Wide-field retinal mosaic image.
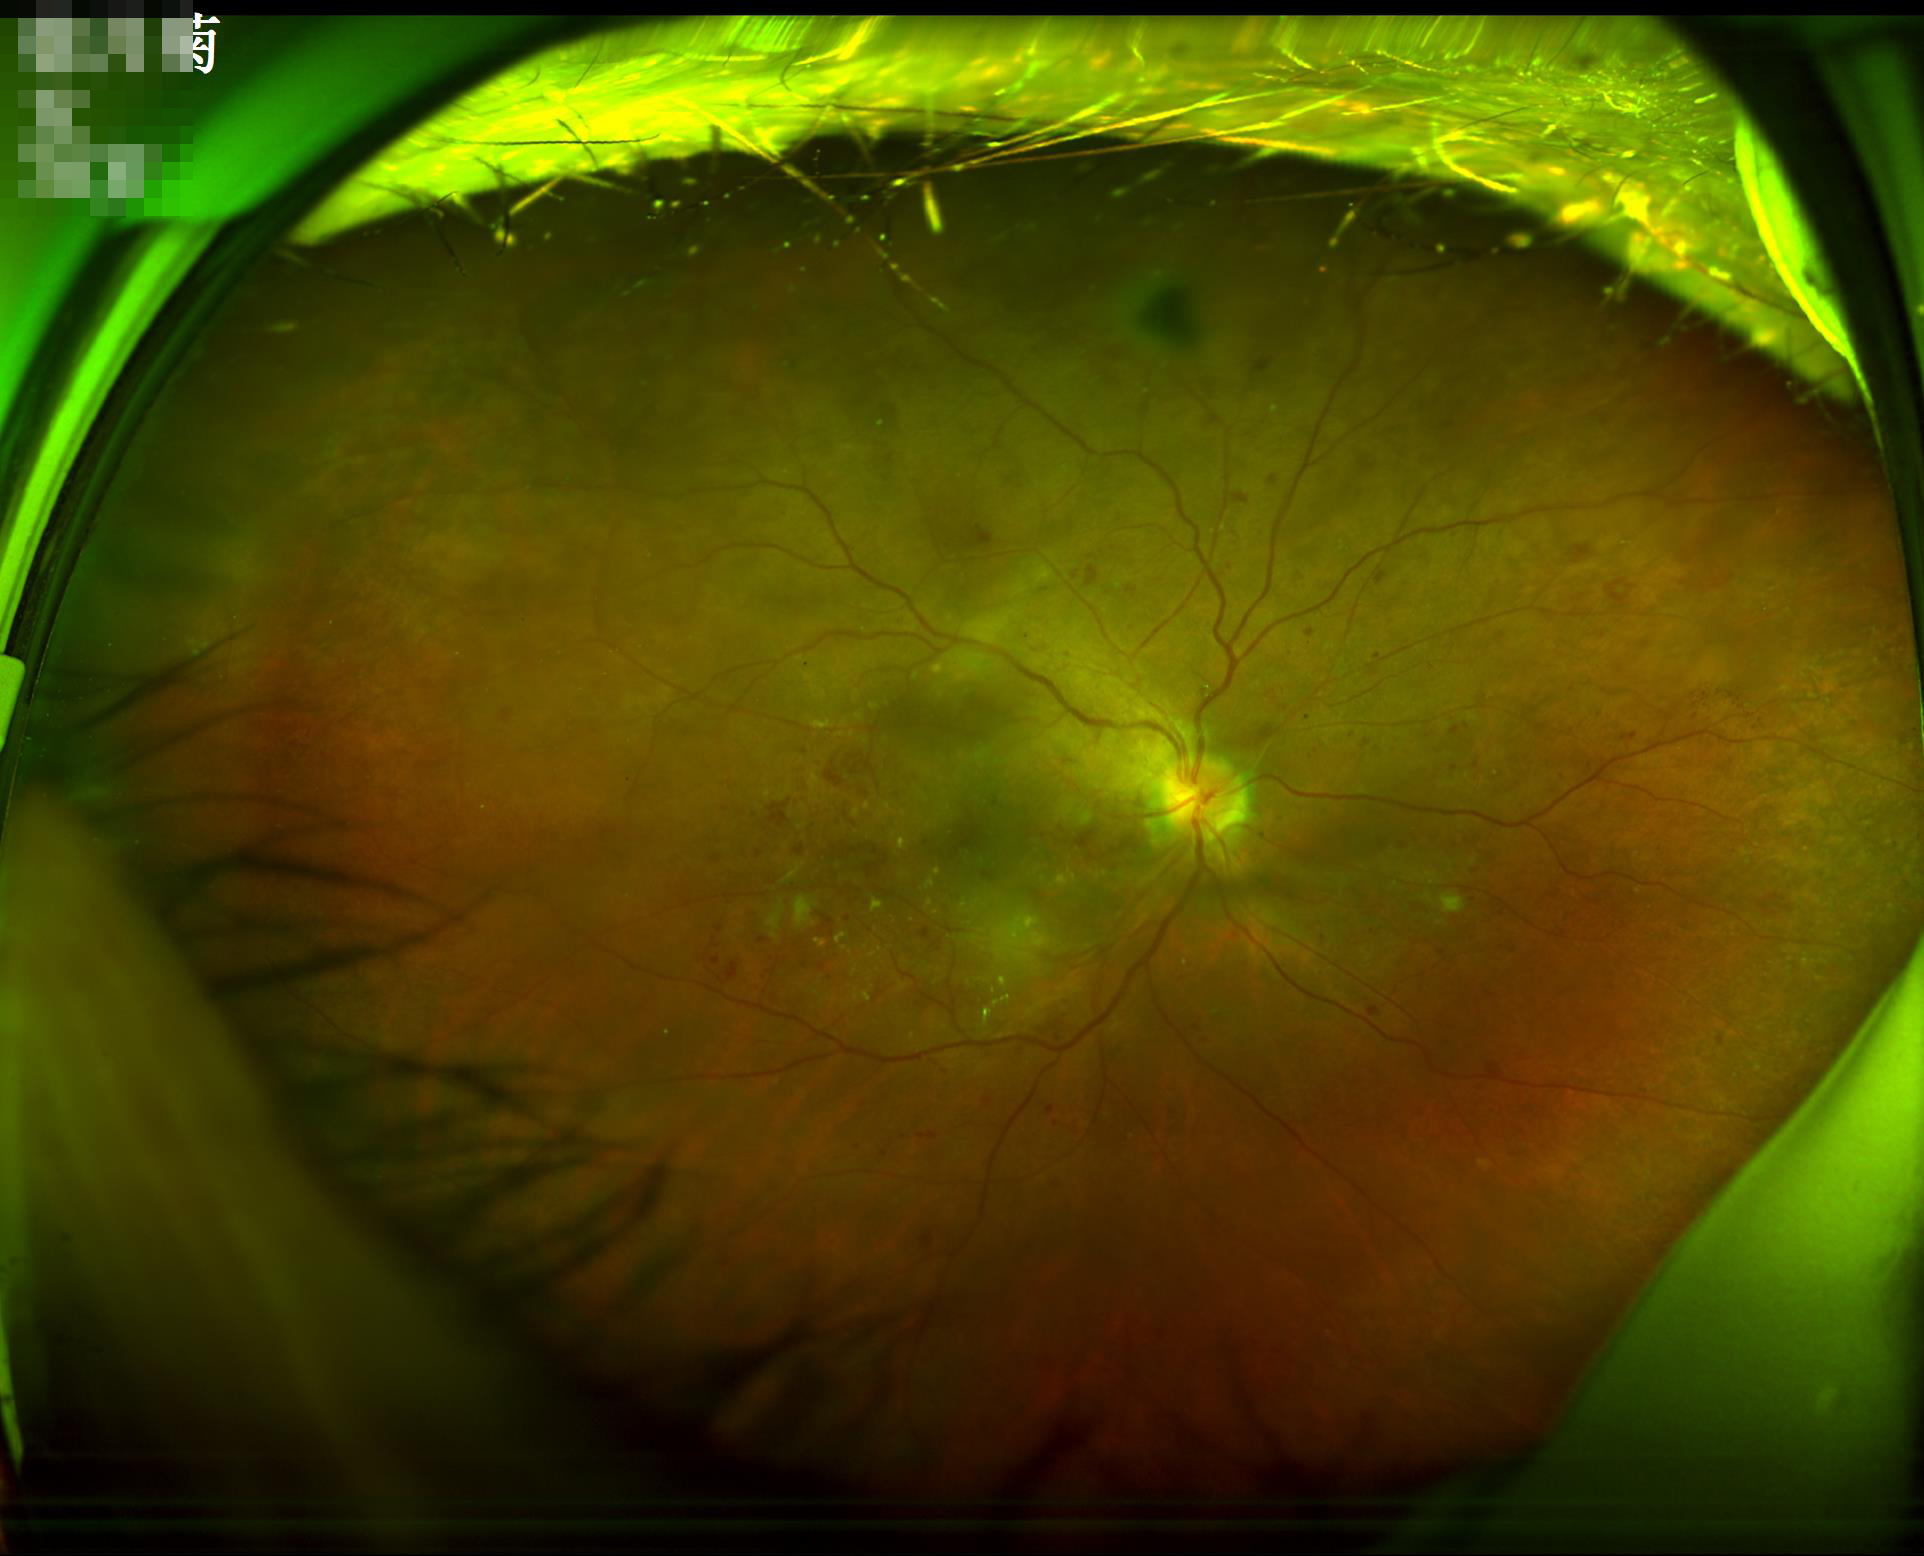
contrast: vessels and details readily distinguishable
illumination: no over- or under-exposure
clarity: optic disc, vessels, and background in focus
overall_quality: good, gradable